Image size 848x848, modified Davis classification.
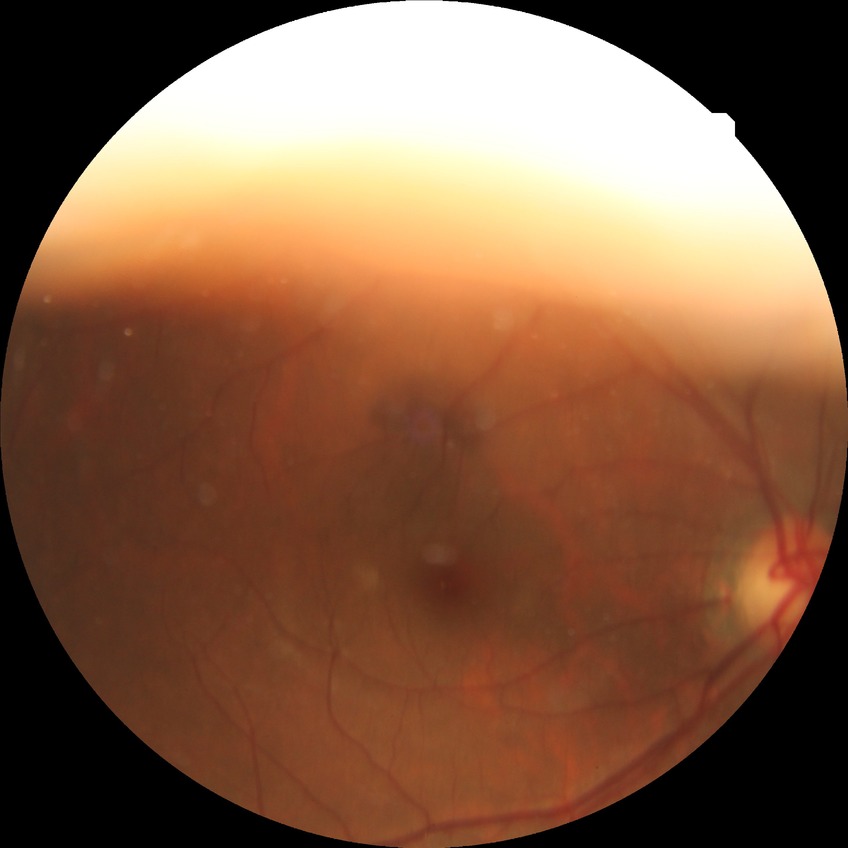 DR class = non-proliferative diabetic retinopathy | diabetic retinopathy (DR) = SDR (simple diabetic retinopathy).